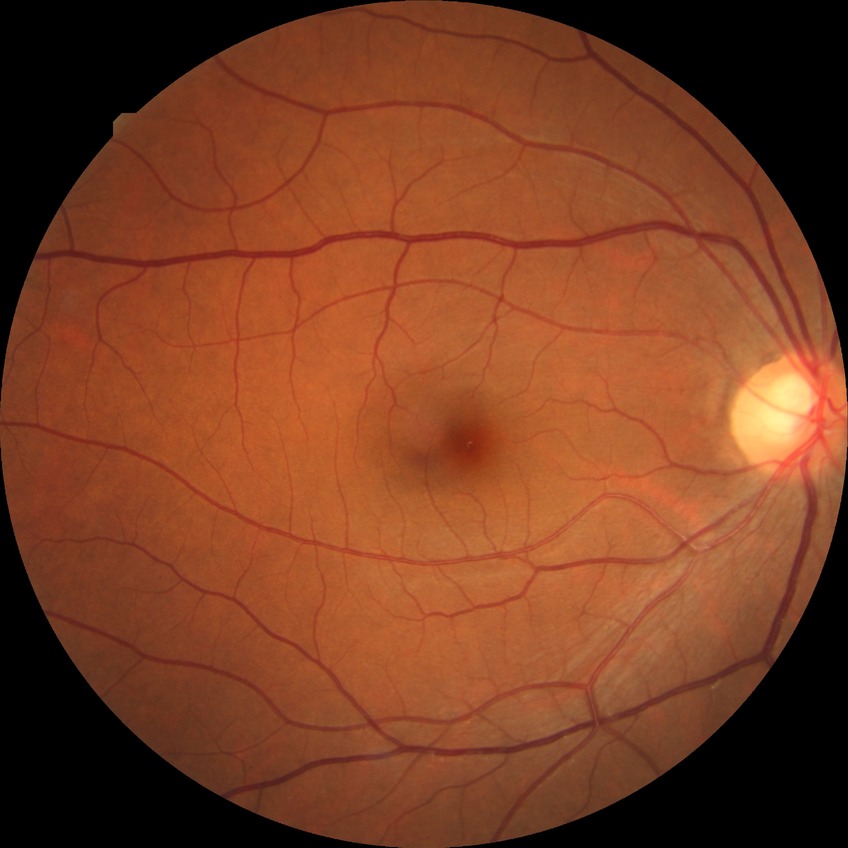 diabetic retinopathy (DR)=NDR (no diabetic retinopathy).